1240 x 1240 pixels. Phoenix ICON wide-field infant fundus image
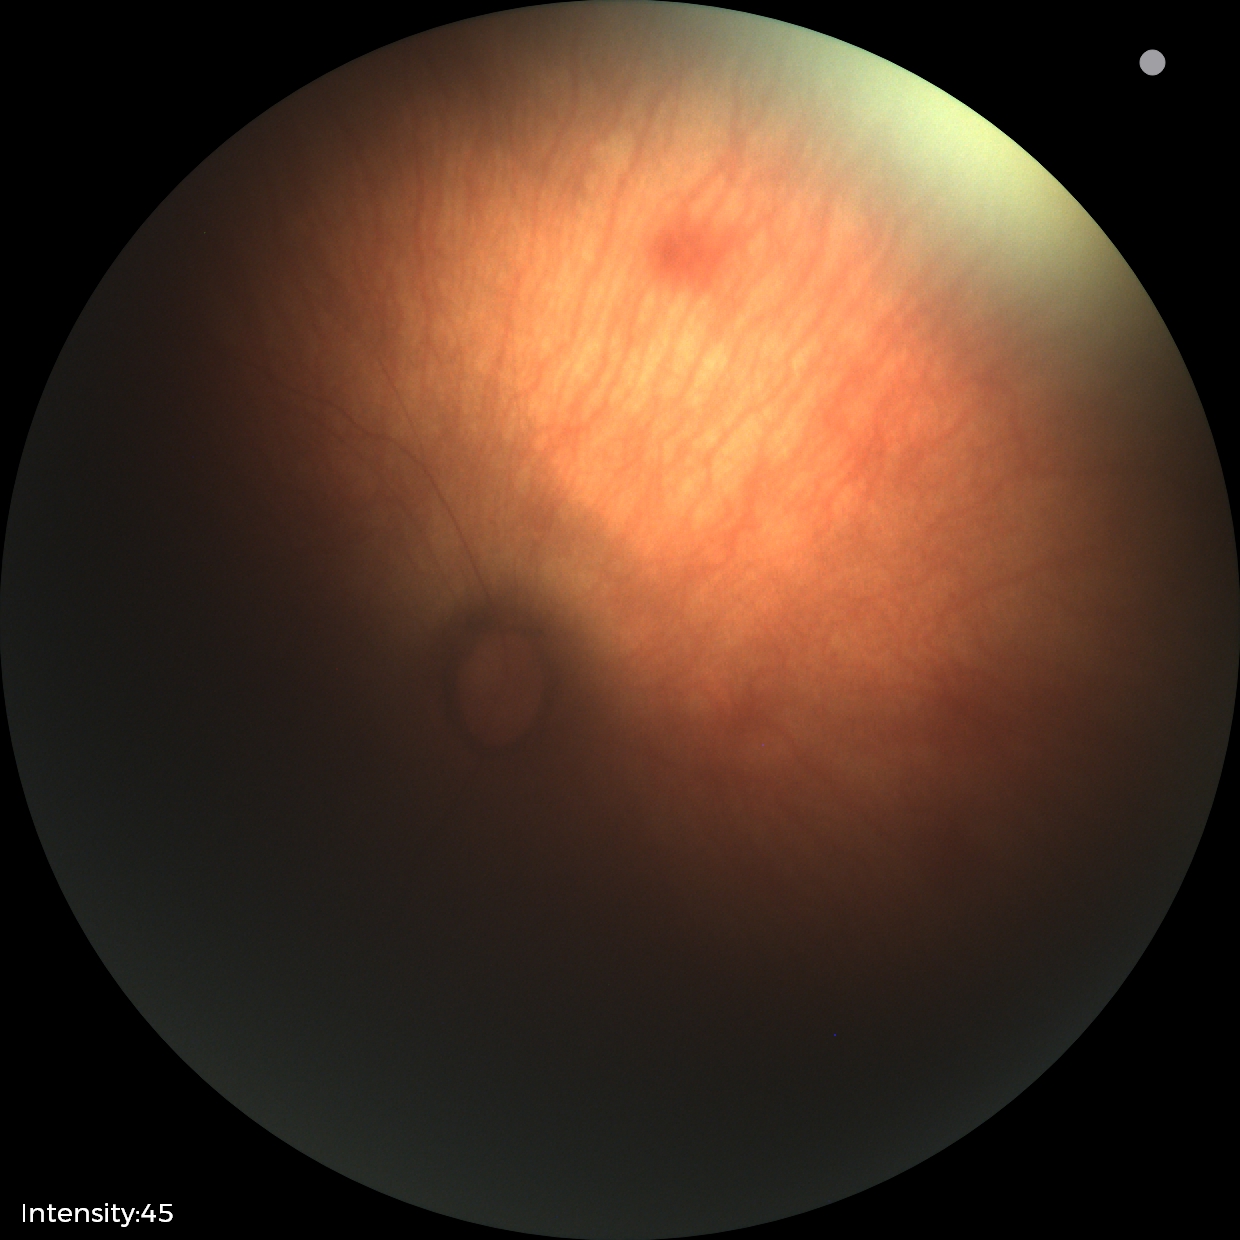 Diagnosis: no pathology identified